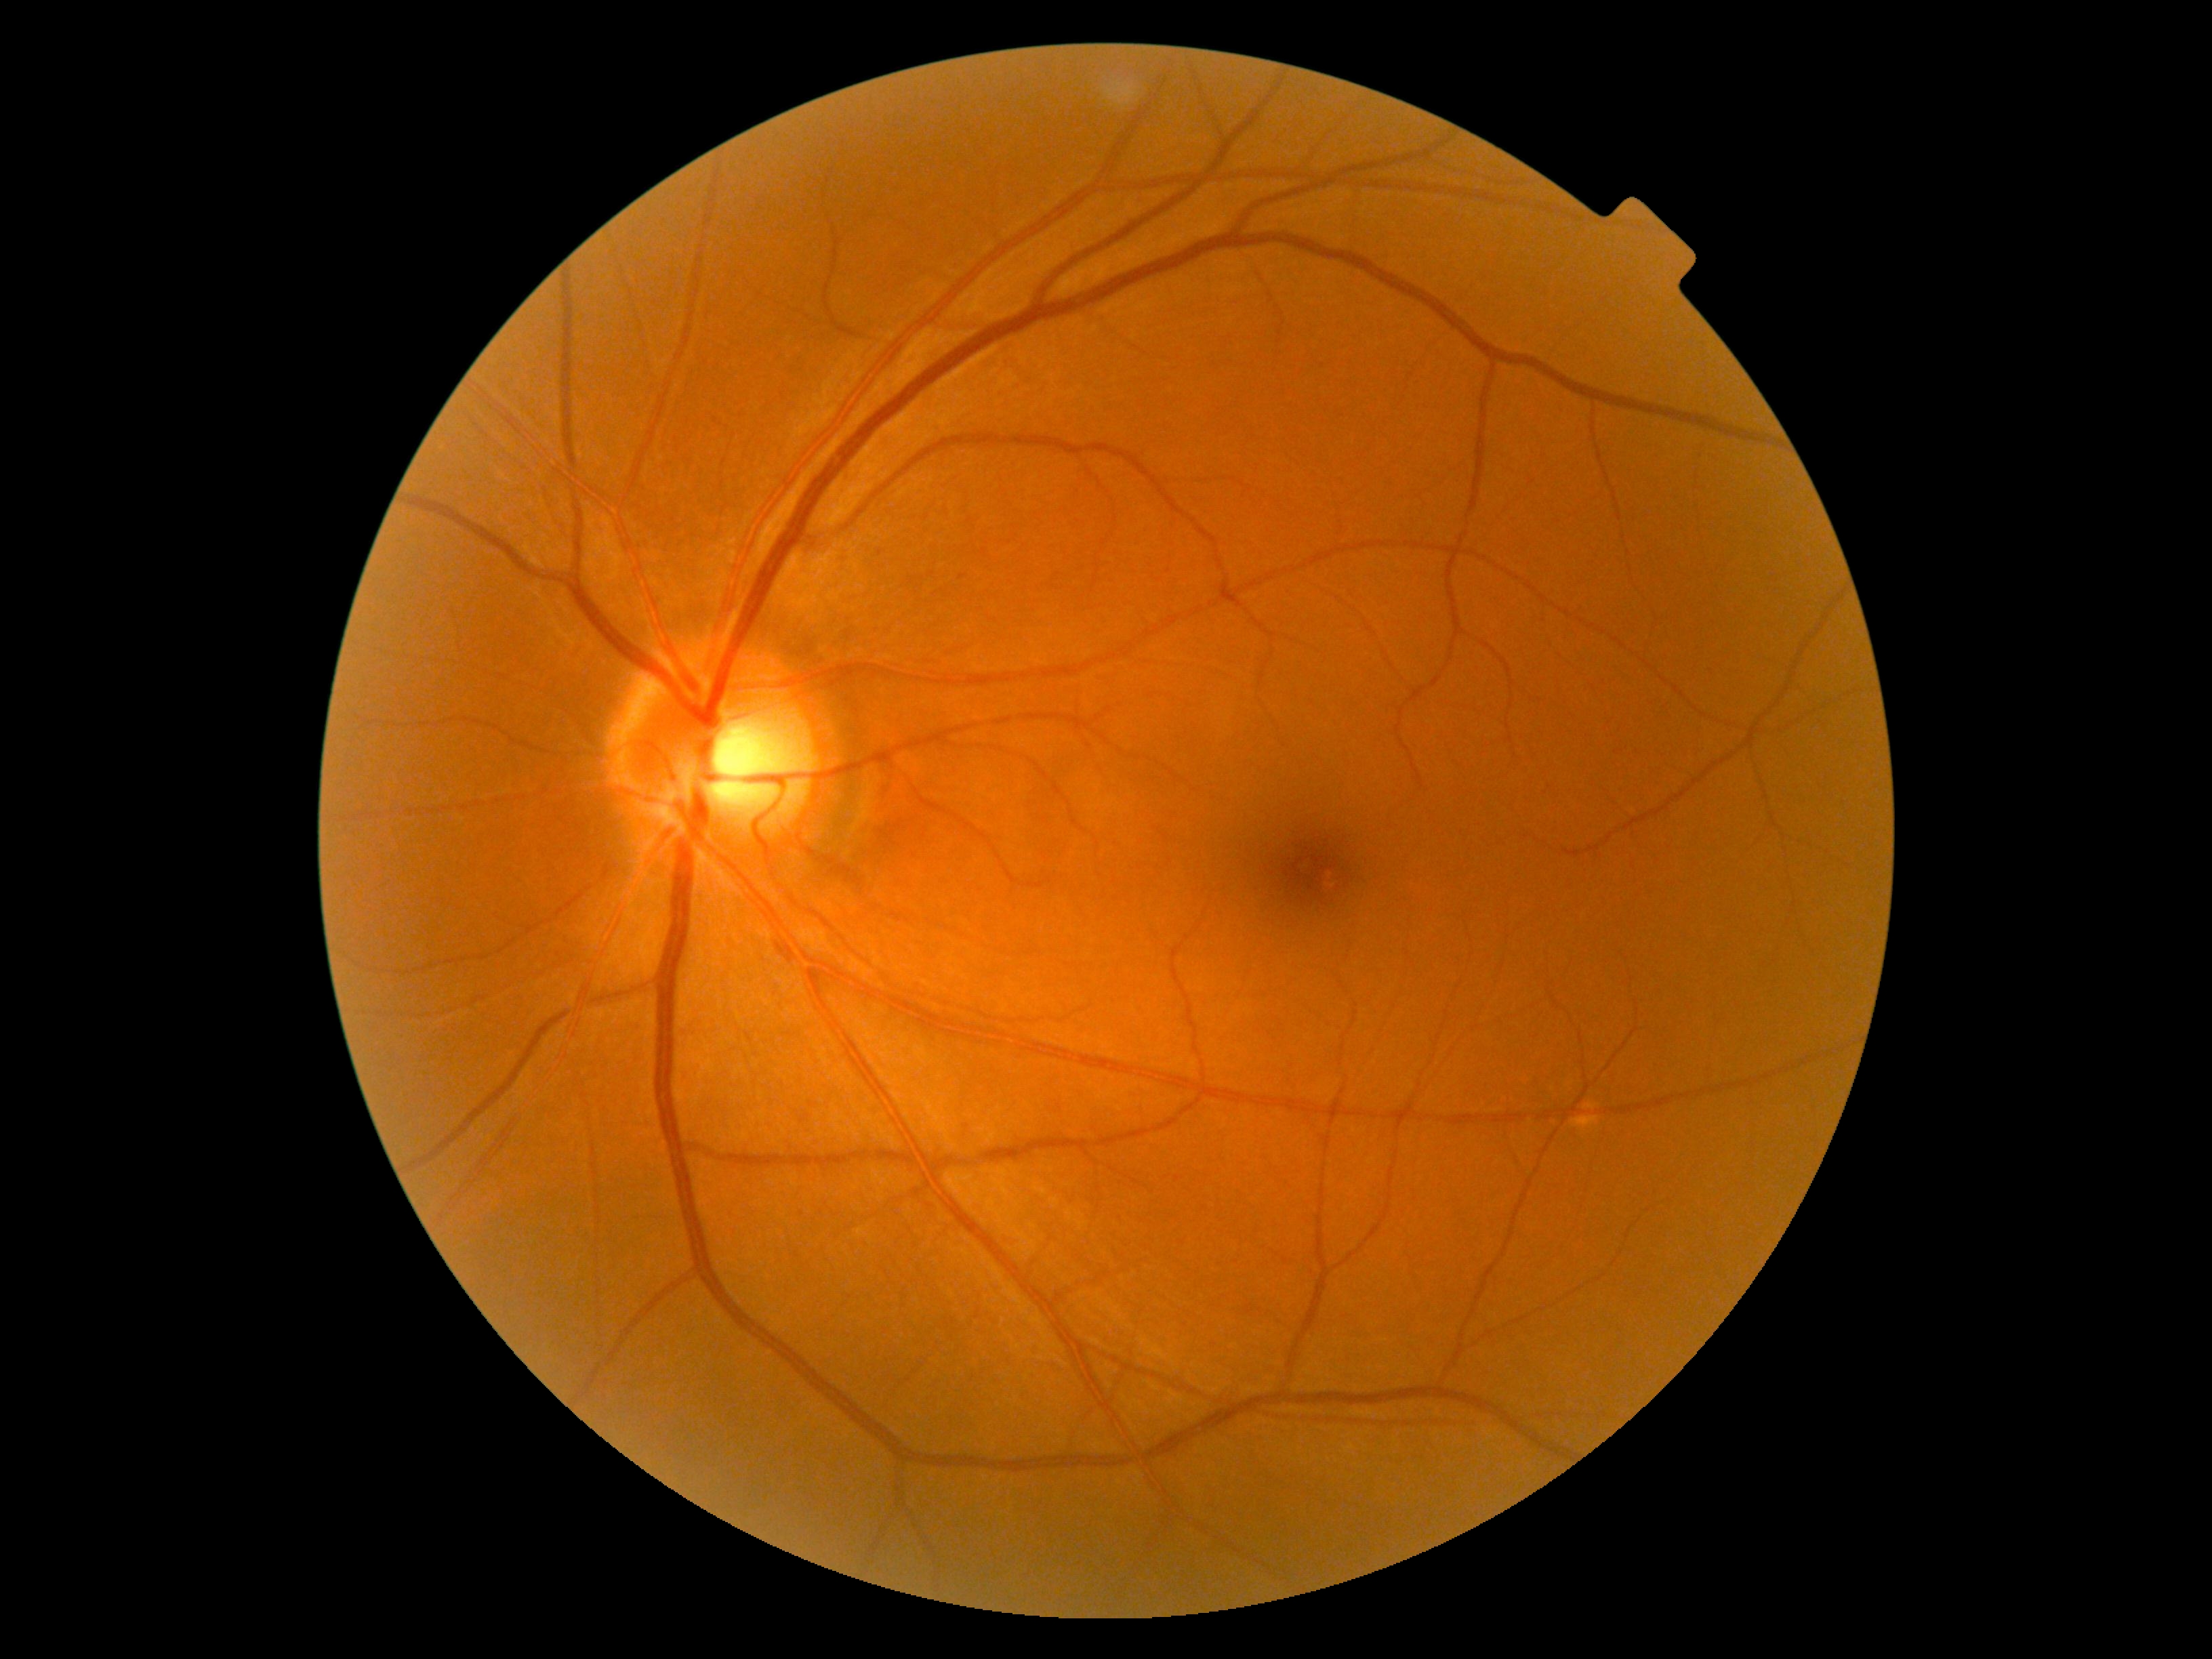
Diabetic retinopathy (DR) is grade 0 (no apparent retinopathy).